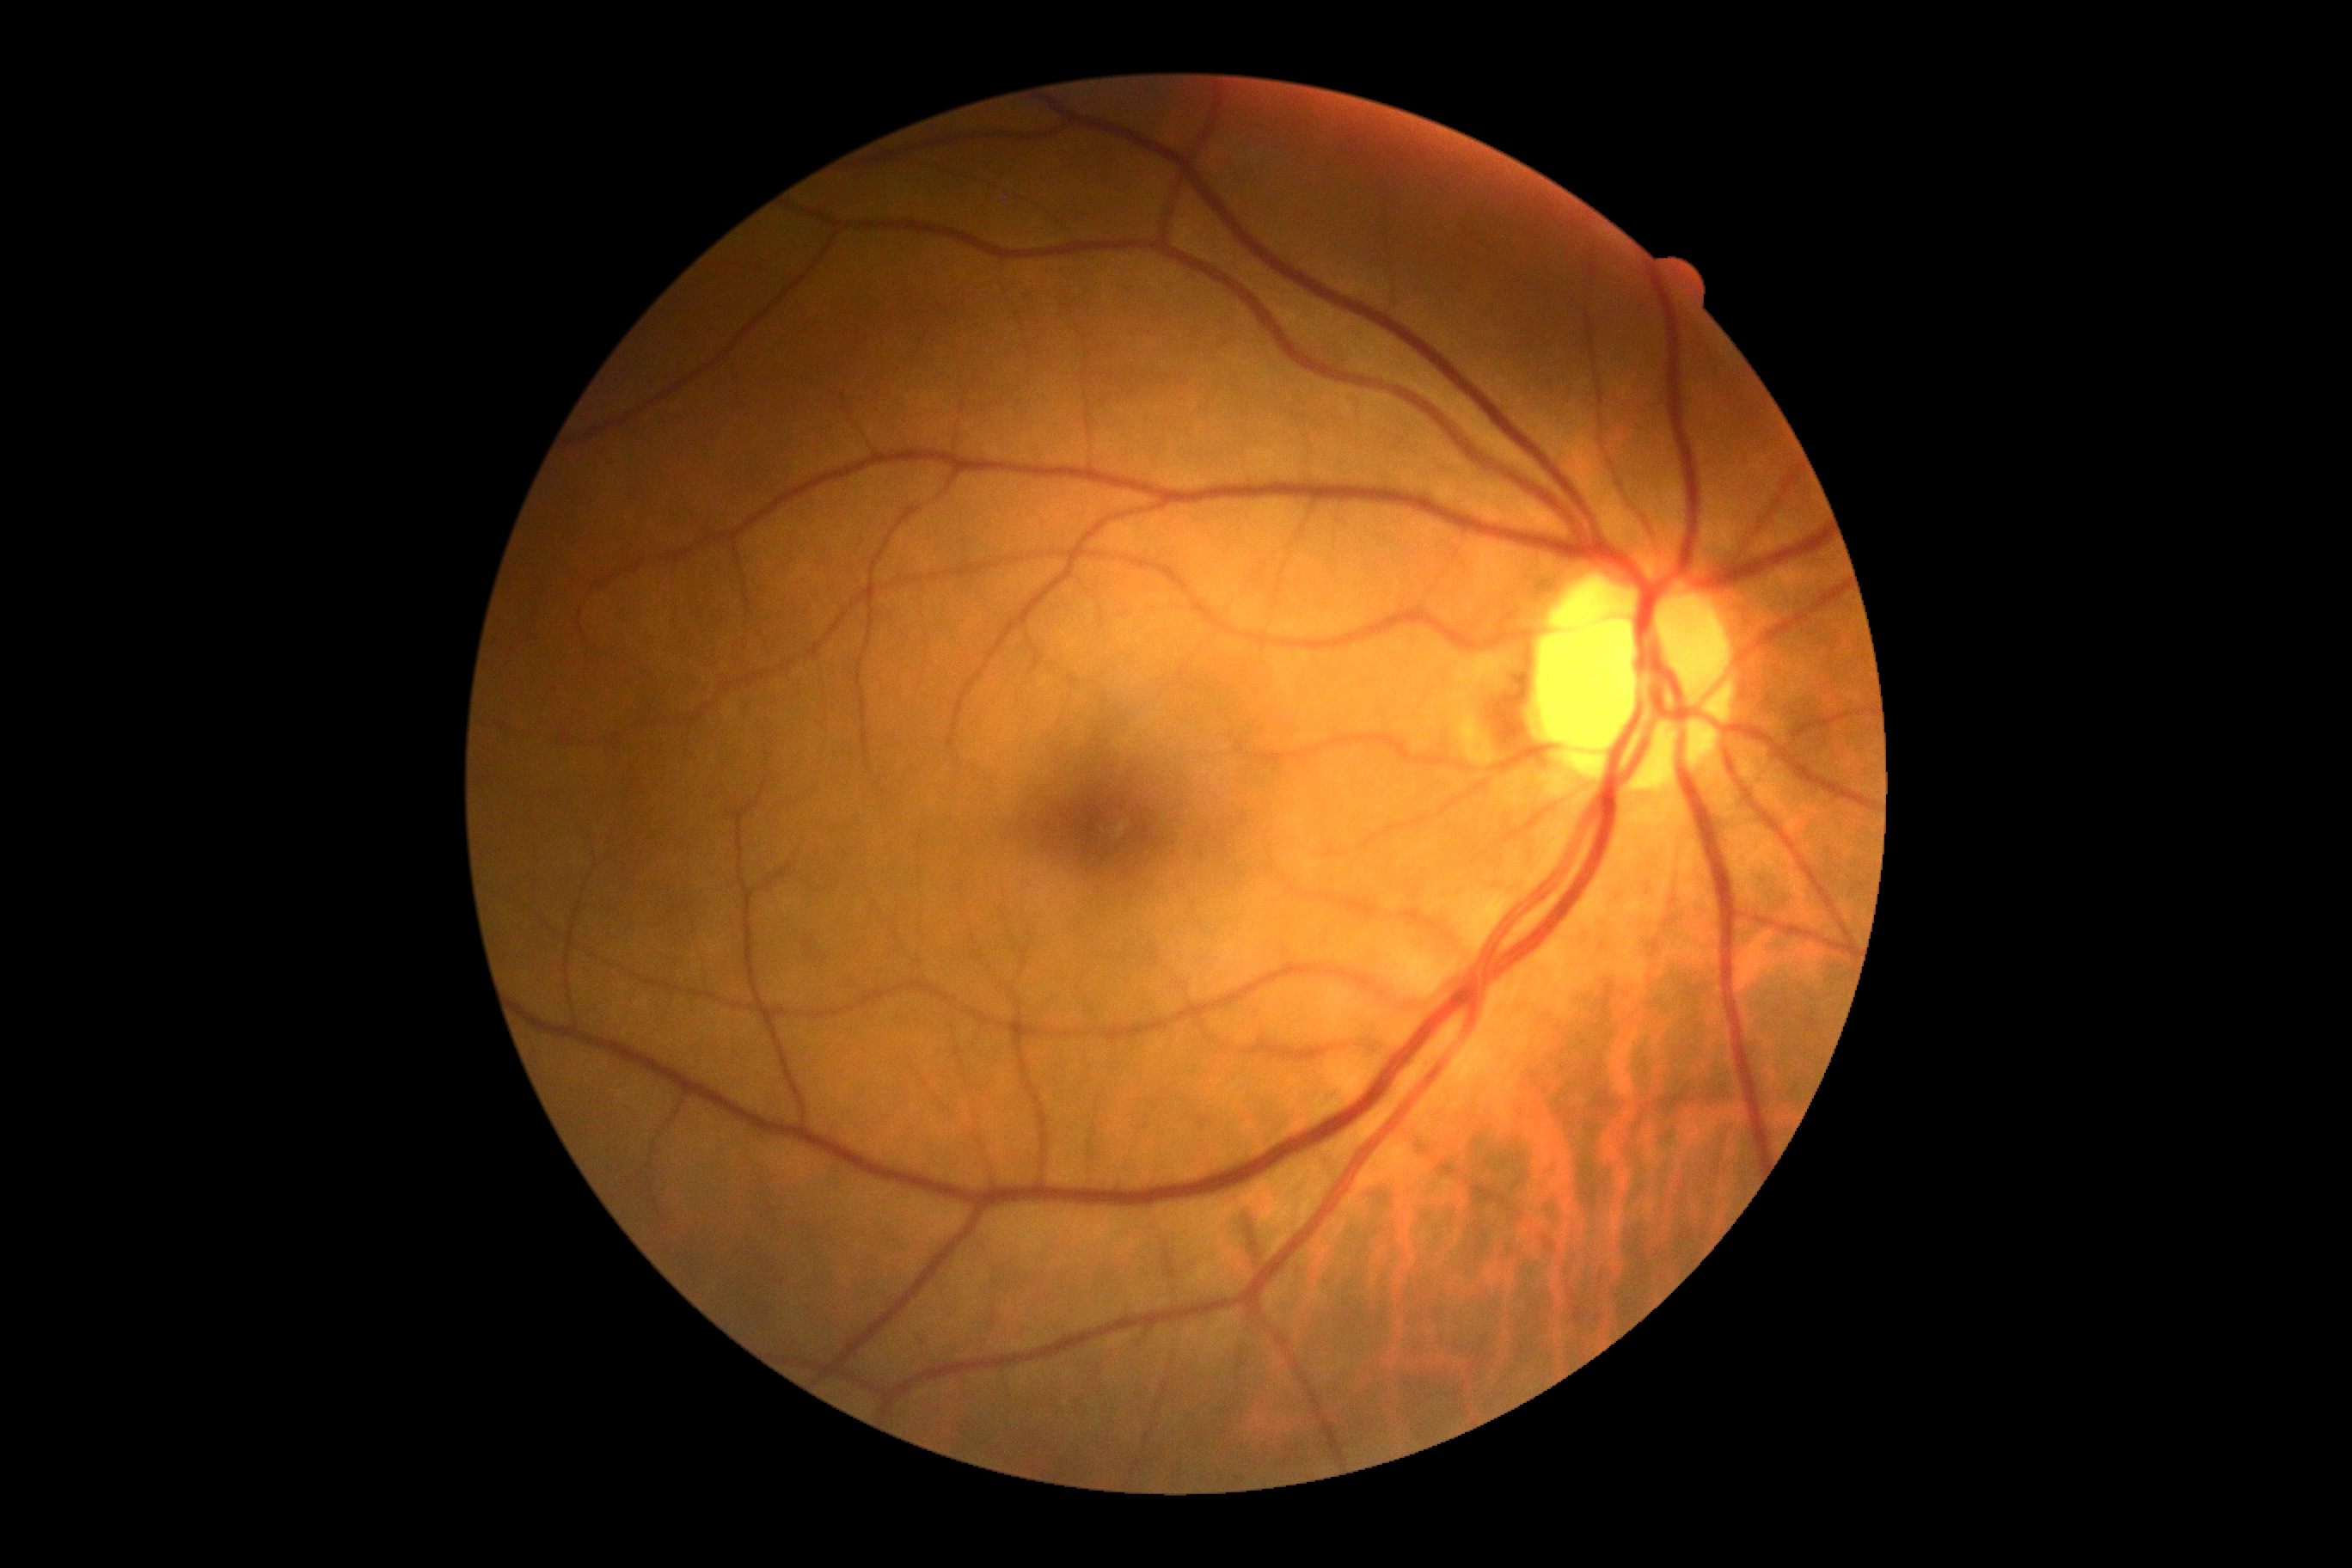
Retinopathy grade: 0 (no apparent retinopathy) — no visible signs of diabetic retinopathy.